130° field of view (Clarity RetCam 3) · wide-field fundus photograph from neonatal ROP screening · 640x480px.
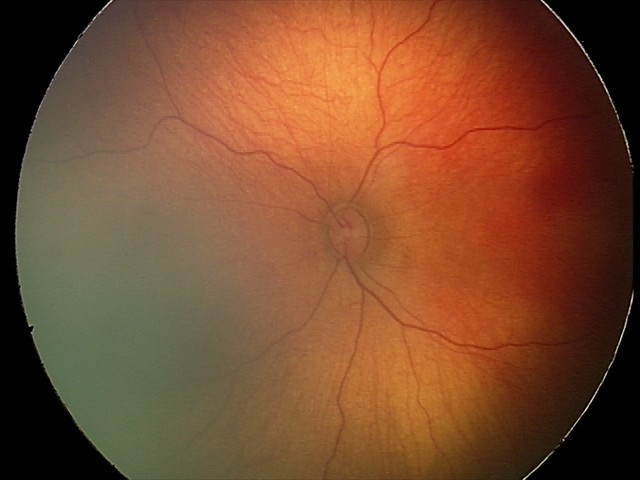

Examination with physiological retinal findings.